Nonmydriatic, modified Davis classification — 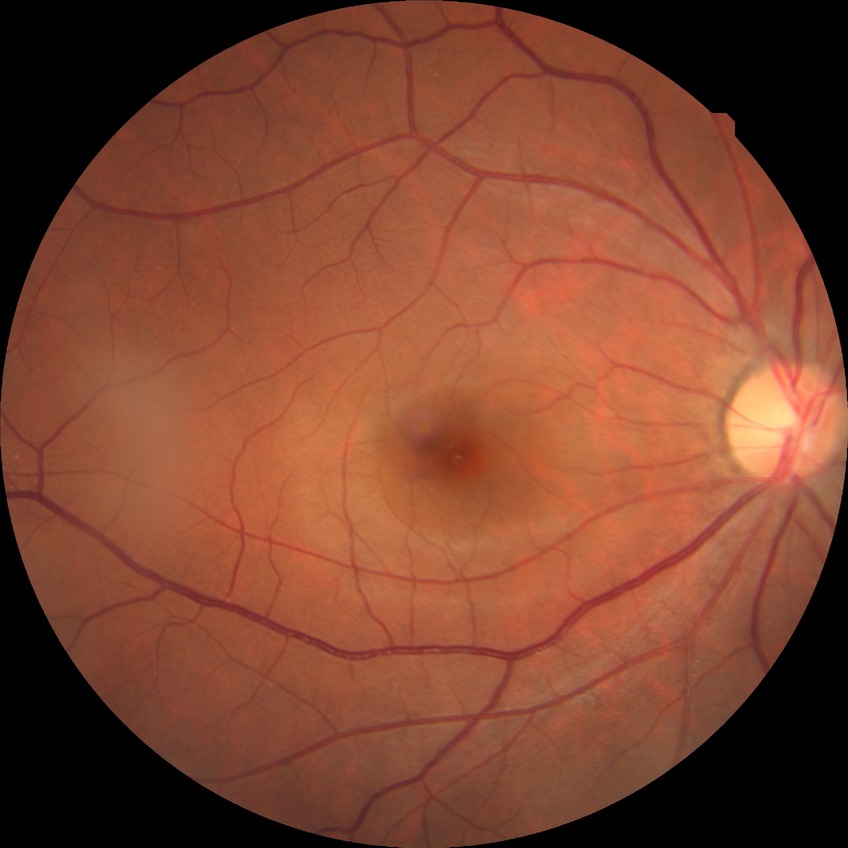 Retinopathy grade: no diabetic retinopathy.